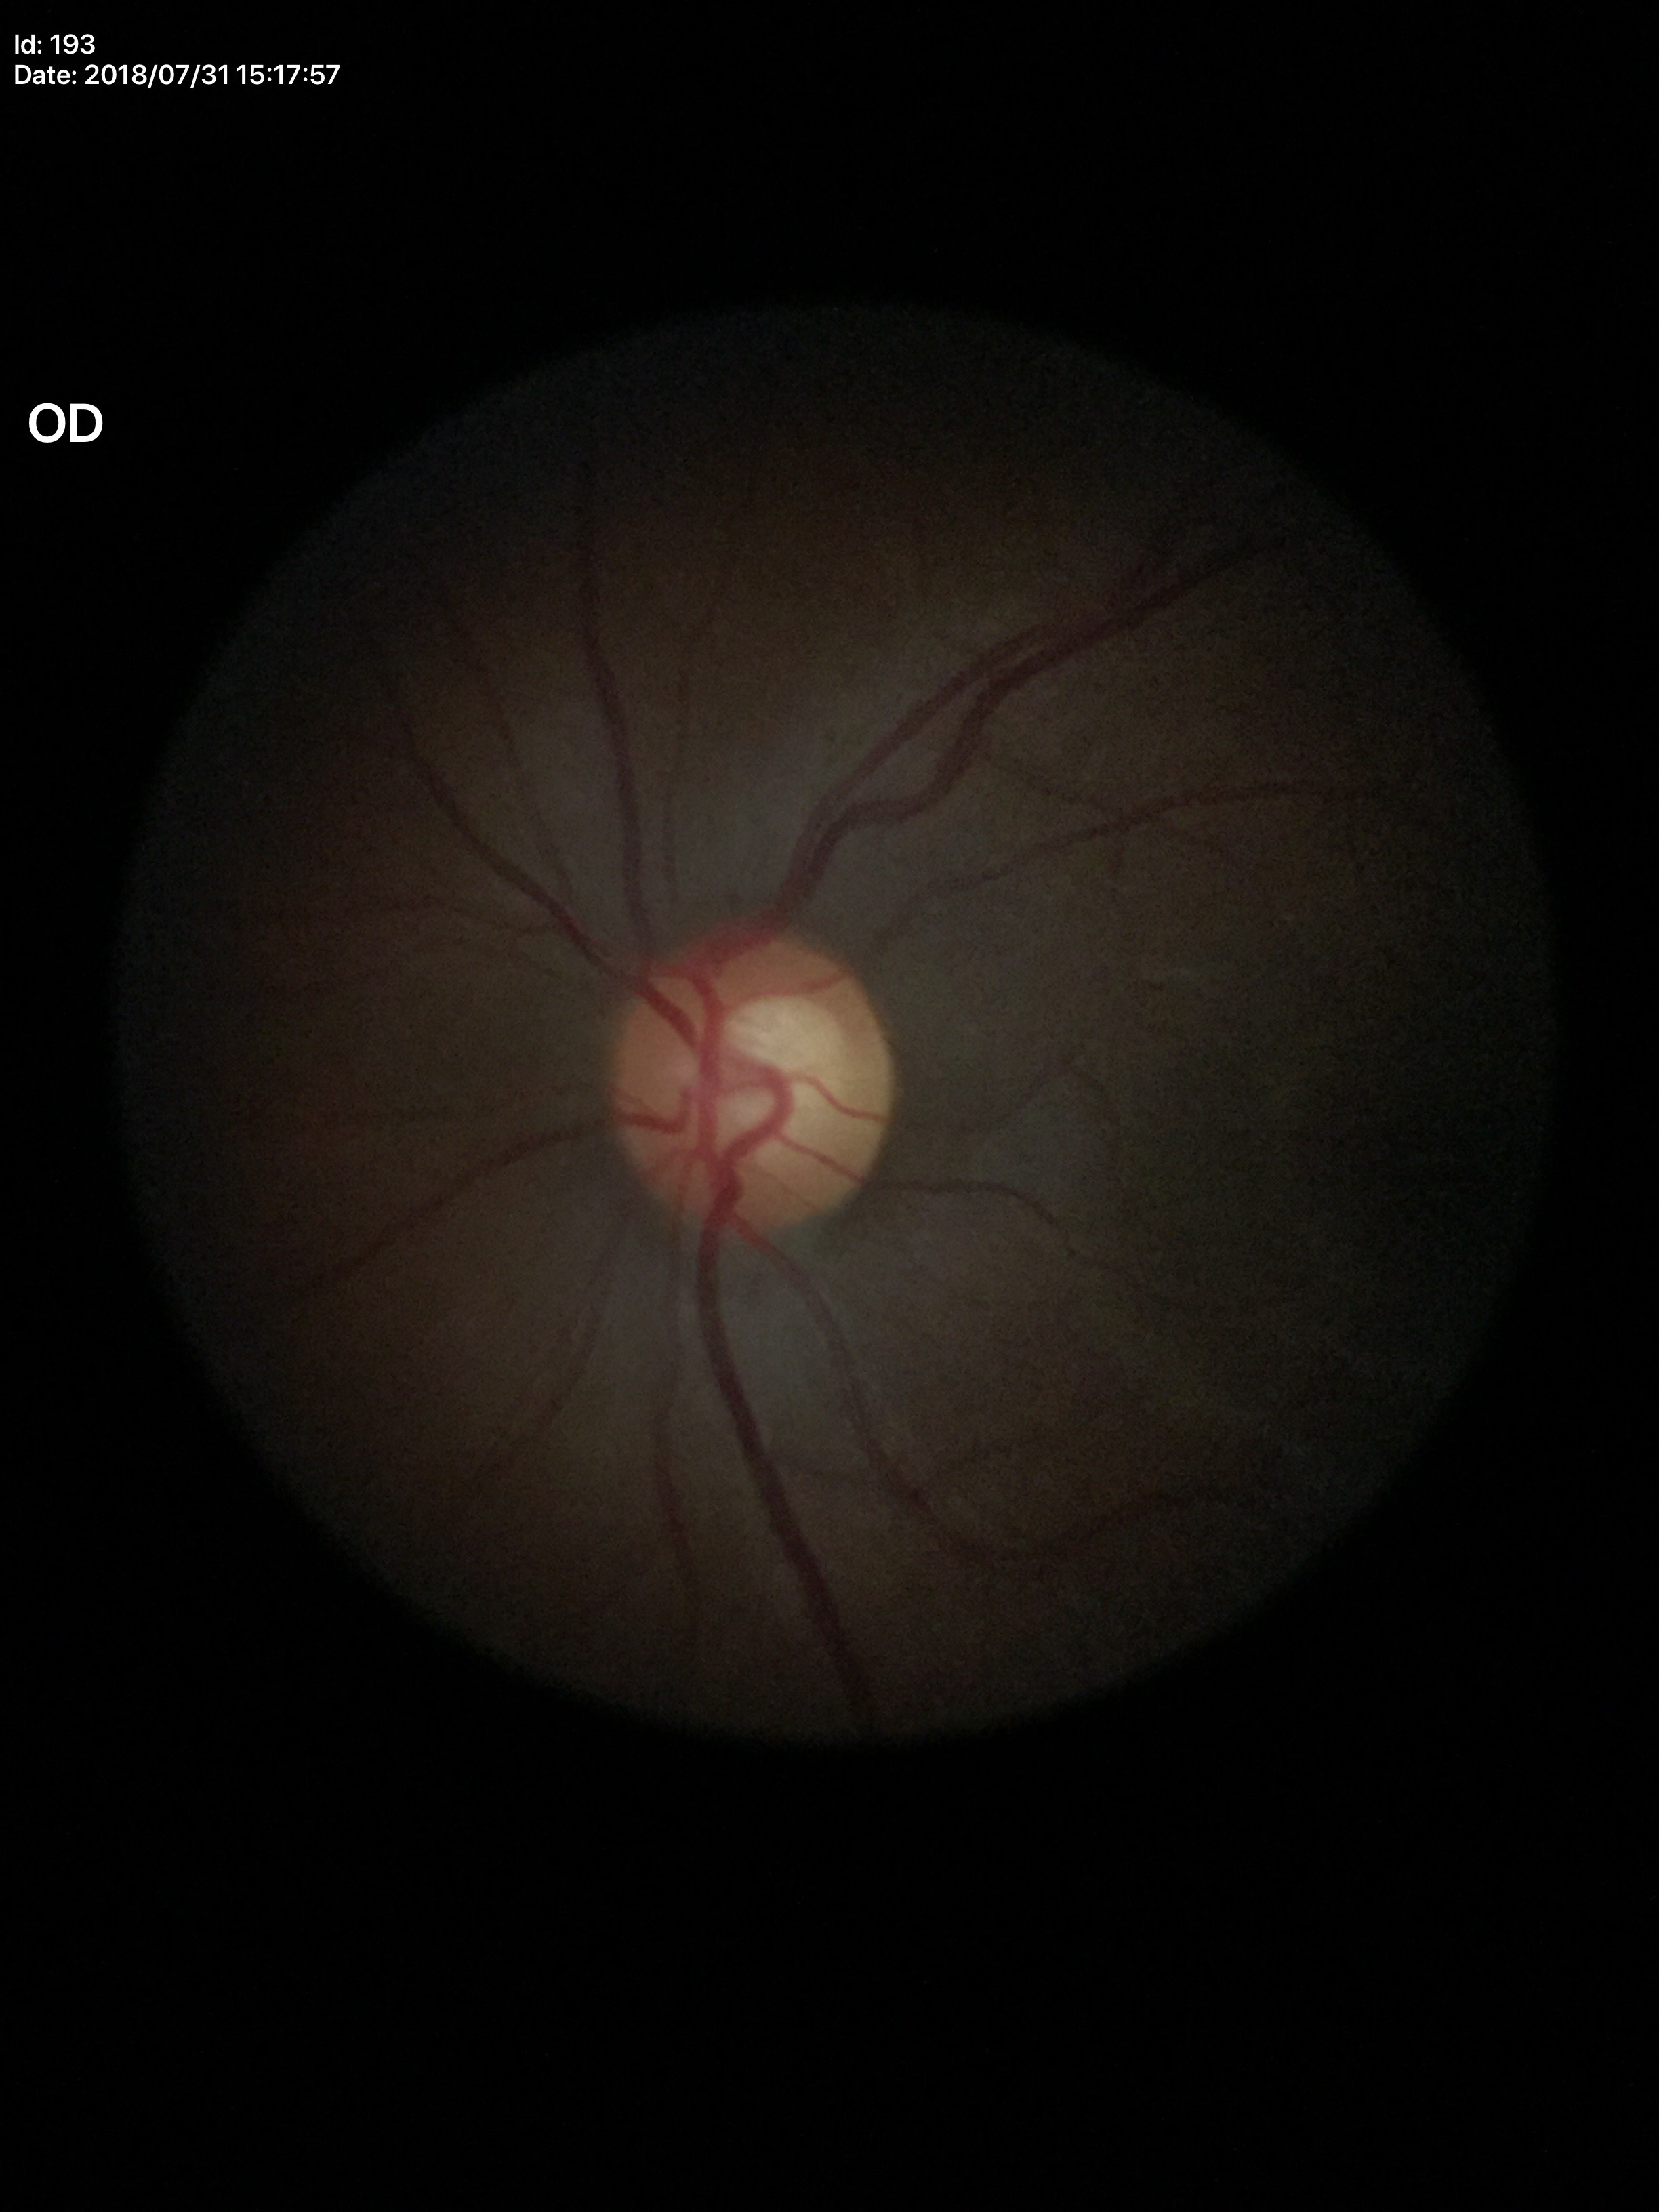

HCDR = 0.61, ACDR = 0.37, Glaucoma assessment = suspect, VCDR = 0.60.